45-degree field of view, graded on the modified Davis scale, nonmydriatic fundus photograph, camera: NIDEK AFC-230 — 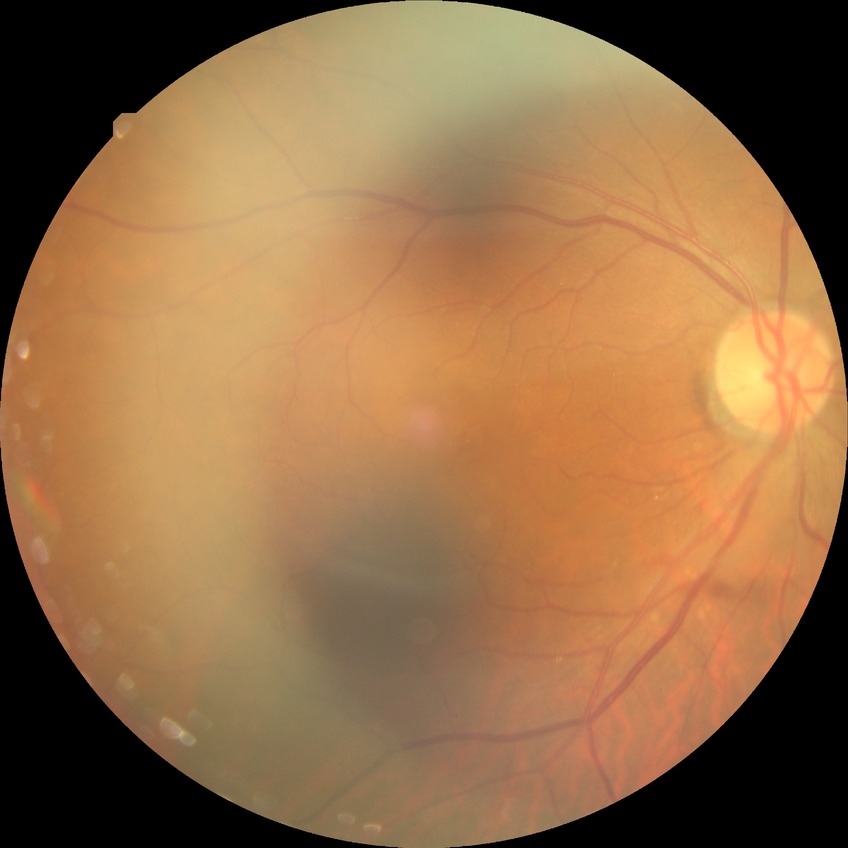

Modified Davis grade: NDR.